Wide-field fundus photograph of an infant; 640x480px
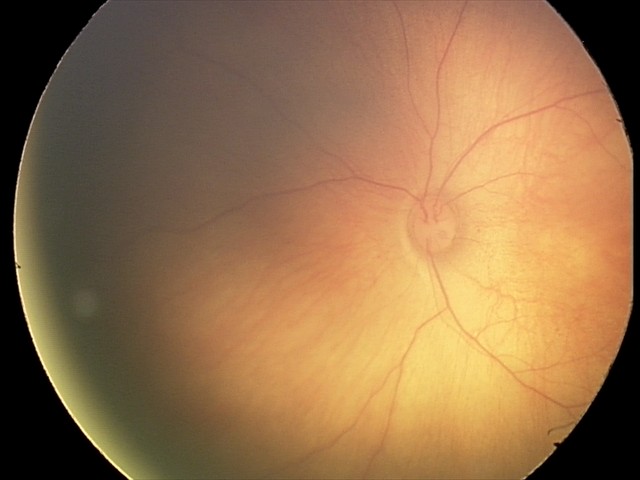 Screening examination consistent with retinal hemorrhages.